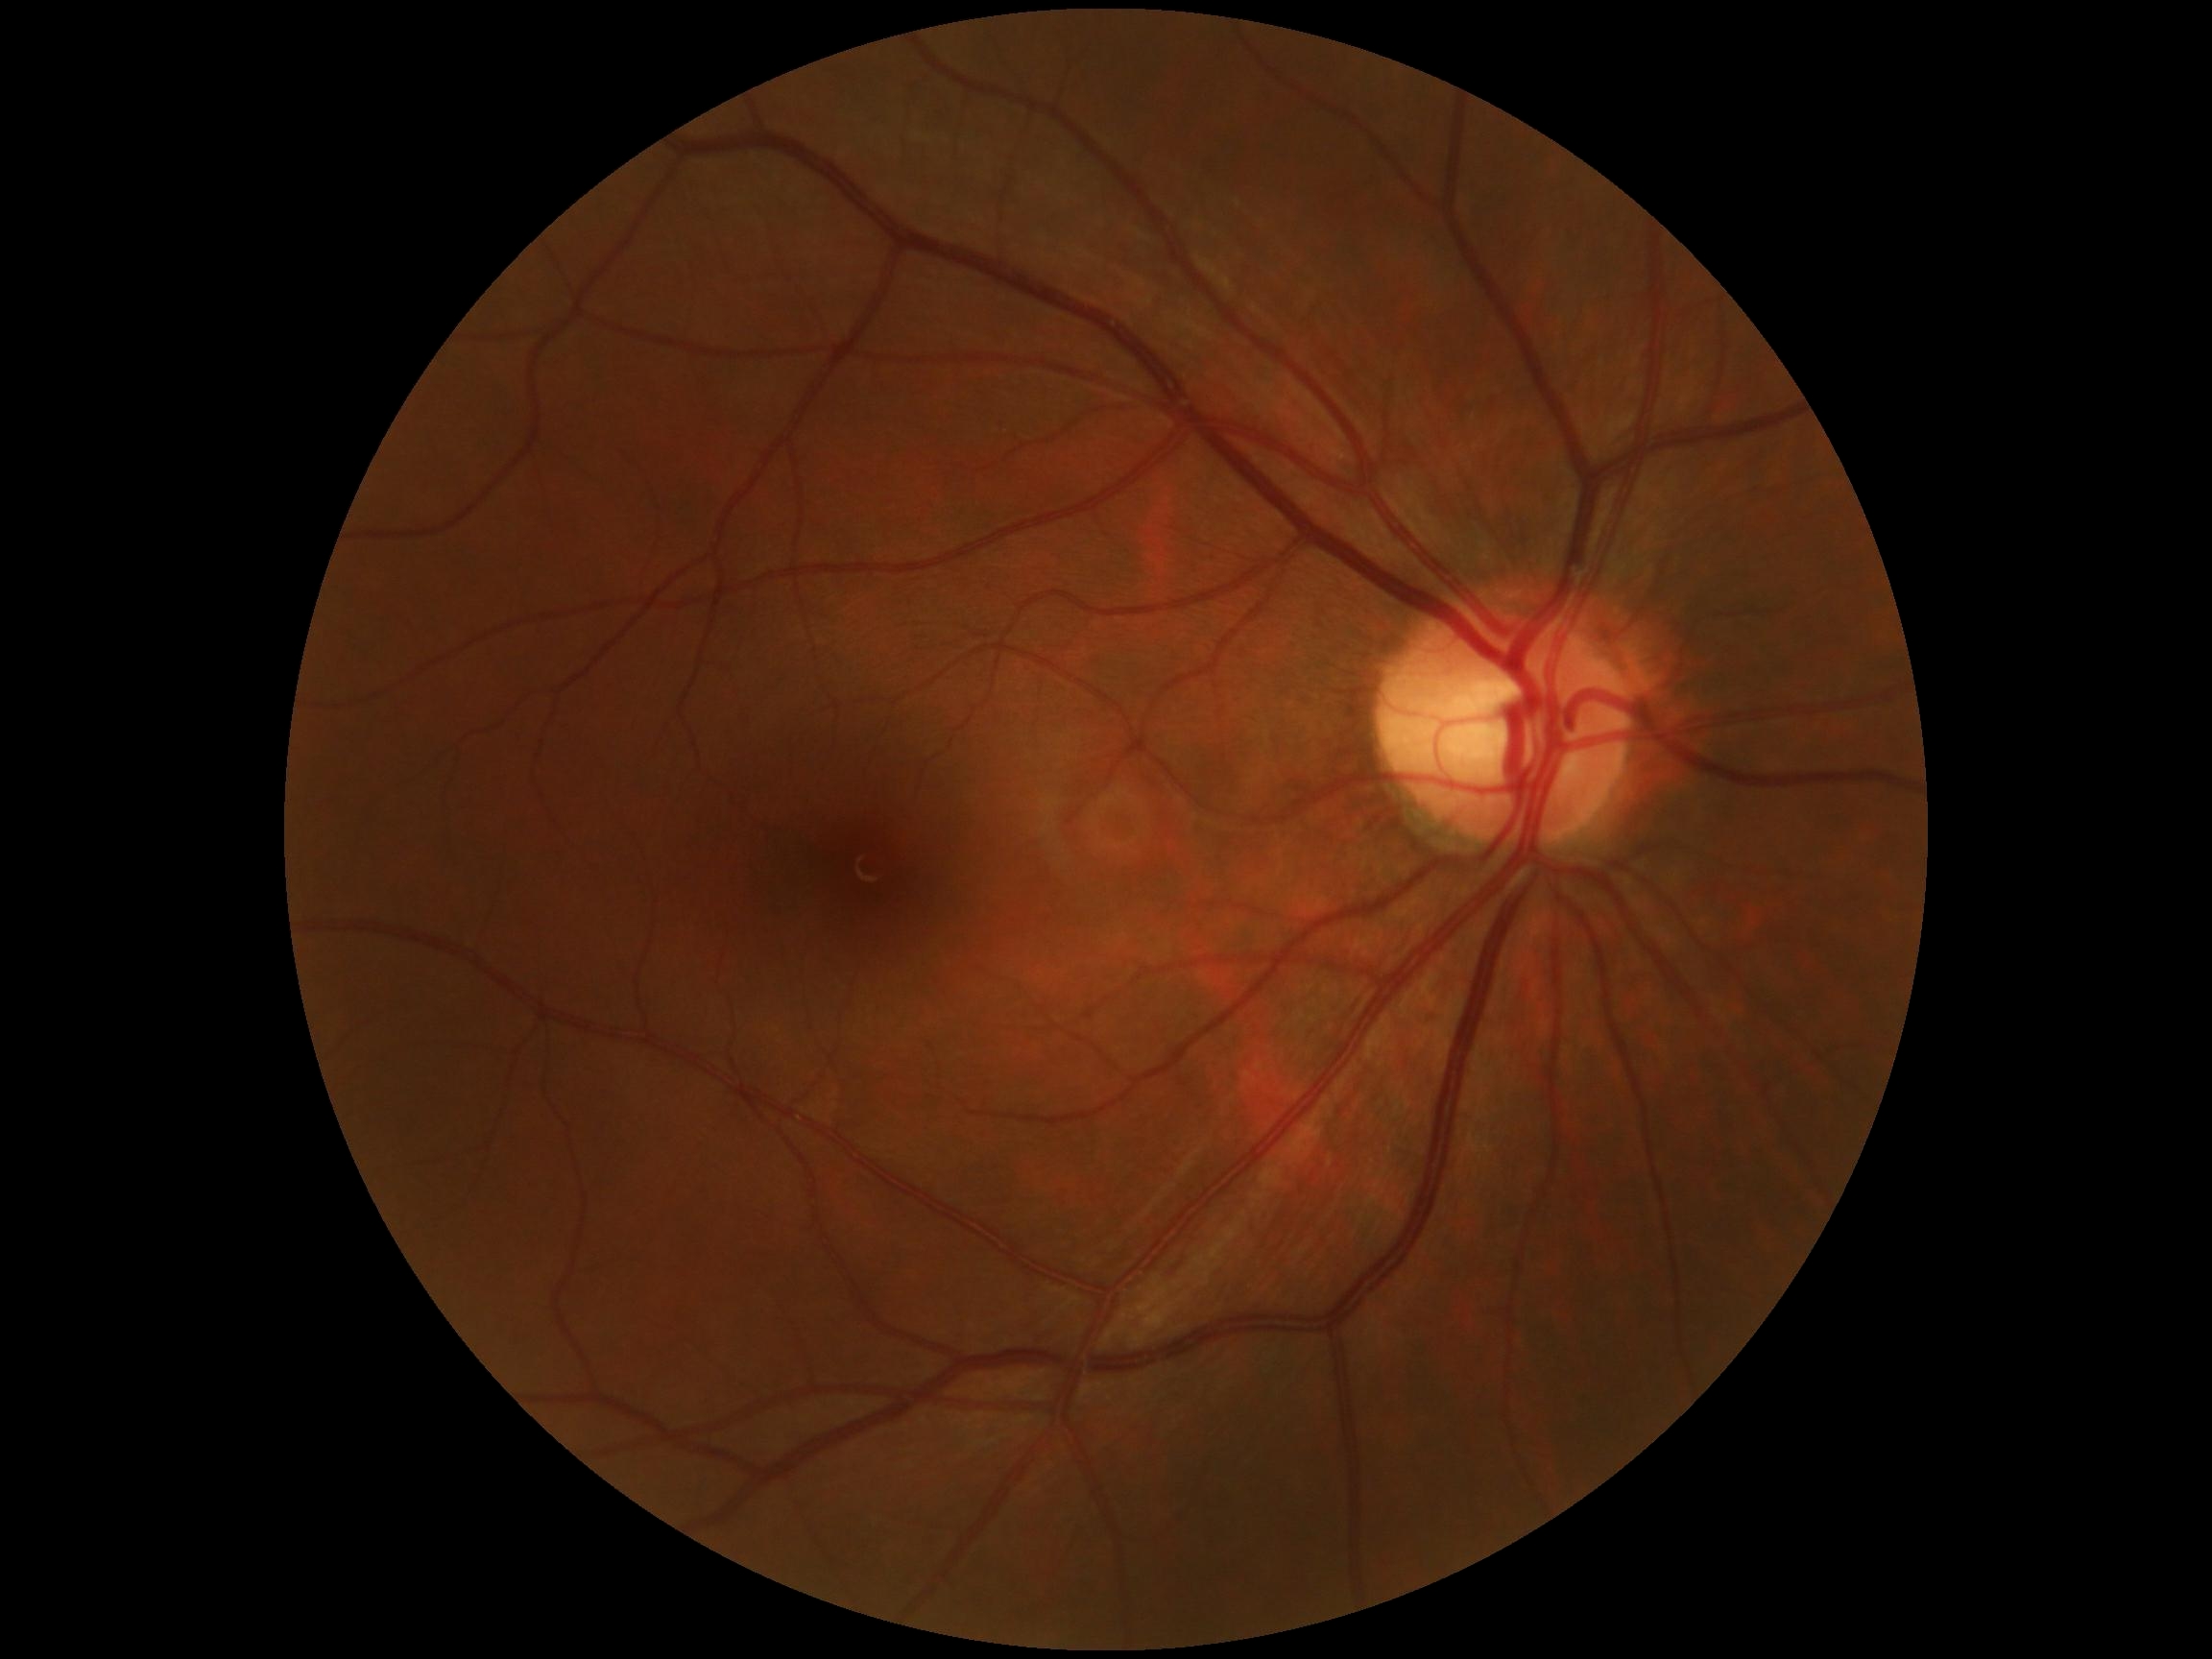
Retinopathy grade: 0 — no visible signs of diabetic retinopathy.
No signs of diabetic retinopathy.